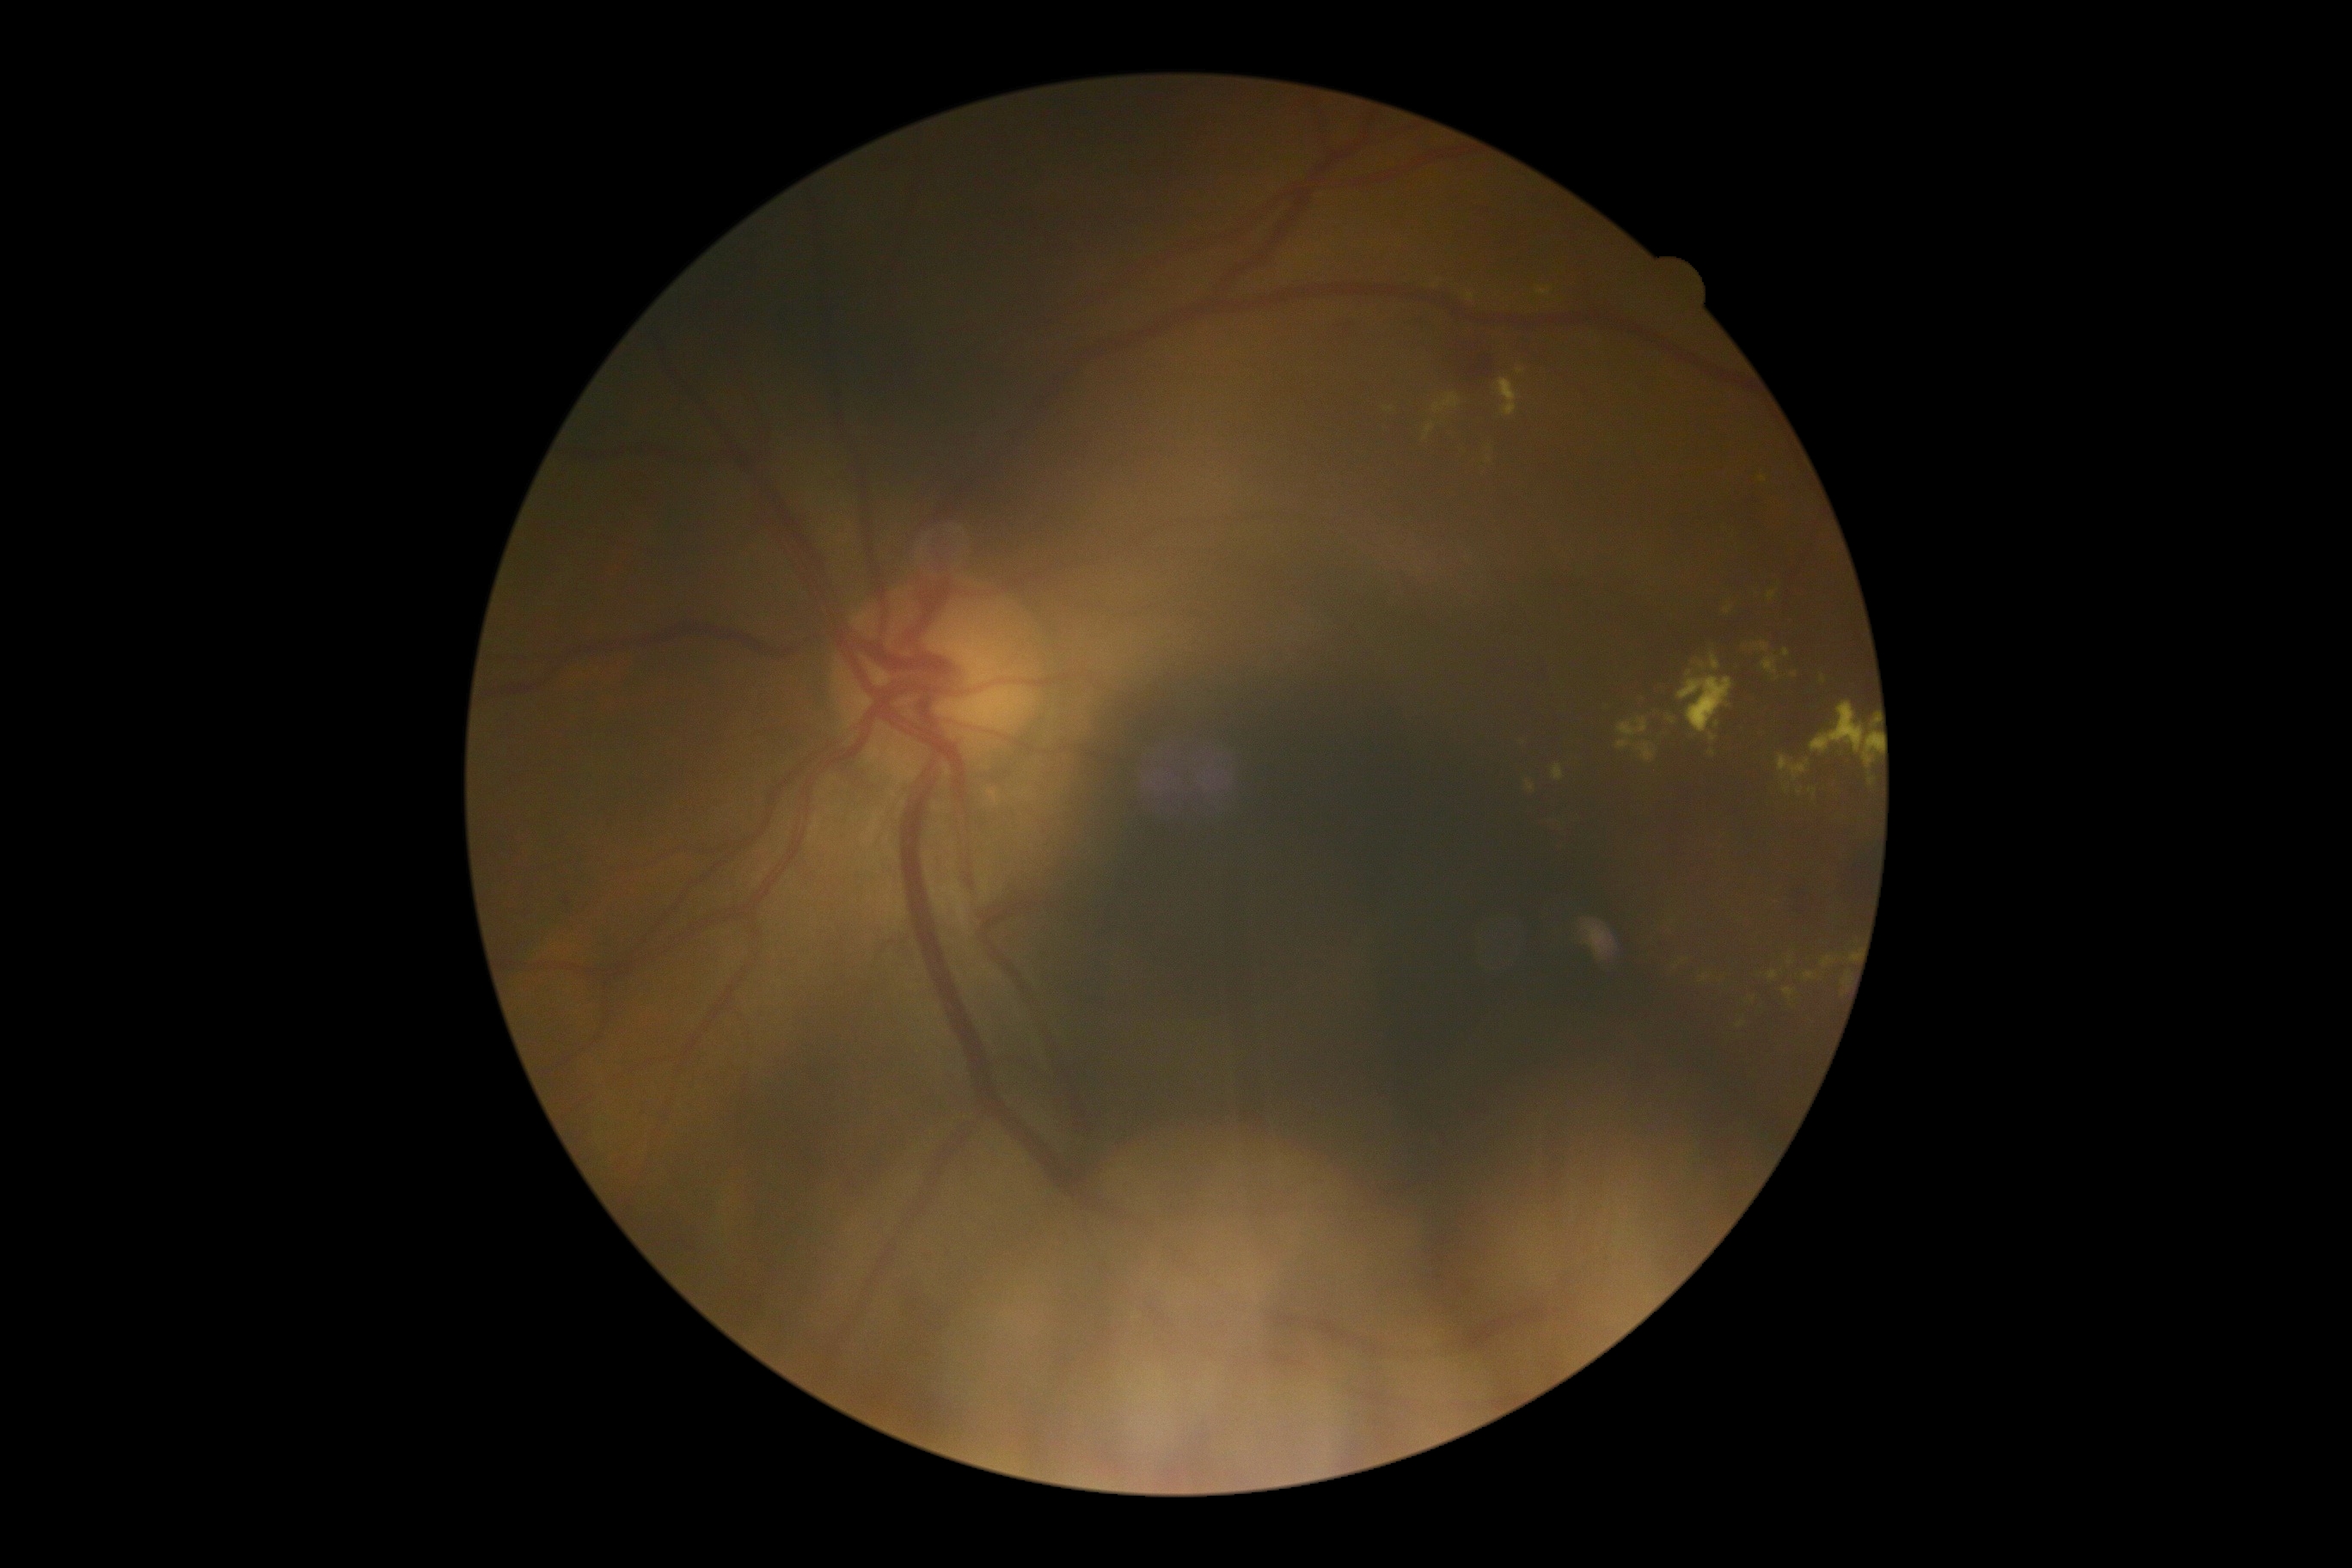 diabetic retinopathy severity = 2.